RetCam wide-field infant fundus image; 640 by 480 pixels; acquired on the Clarity RetCam 3.
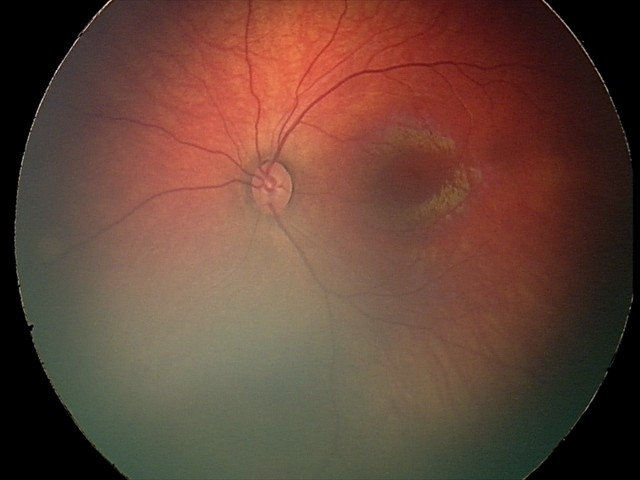

Diagnosis from this screening exam: retinal hemorrhages.